Pupil-dilated
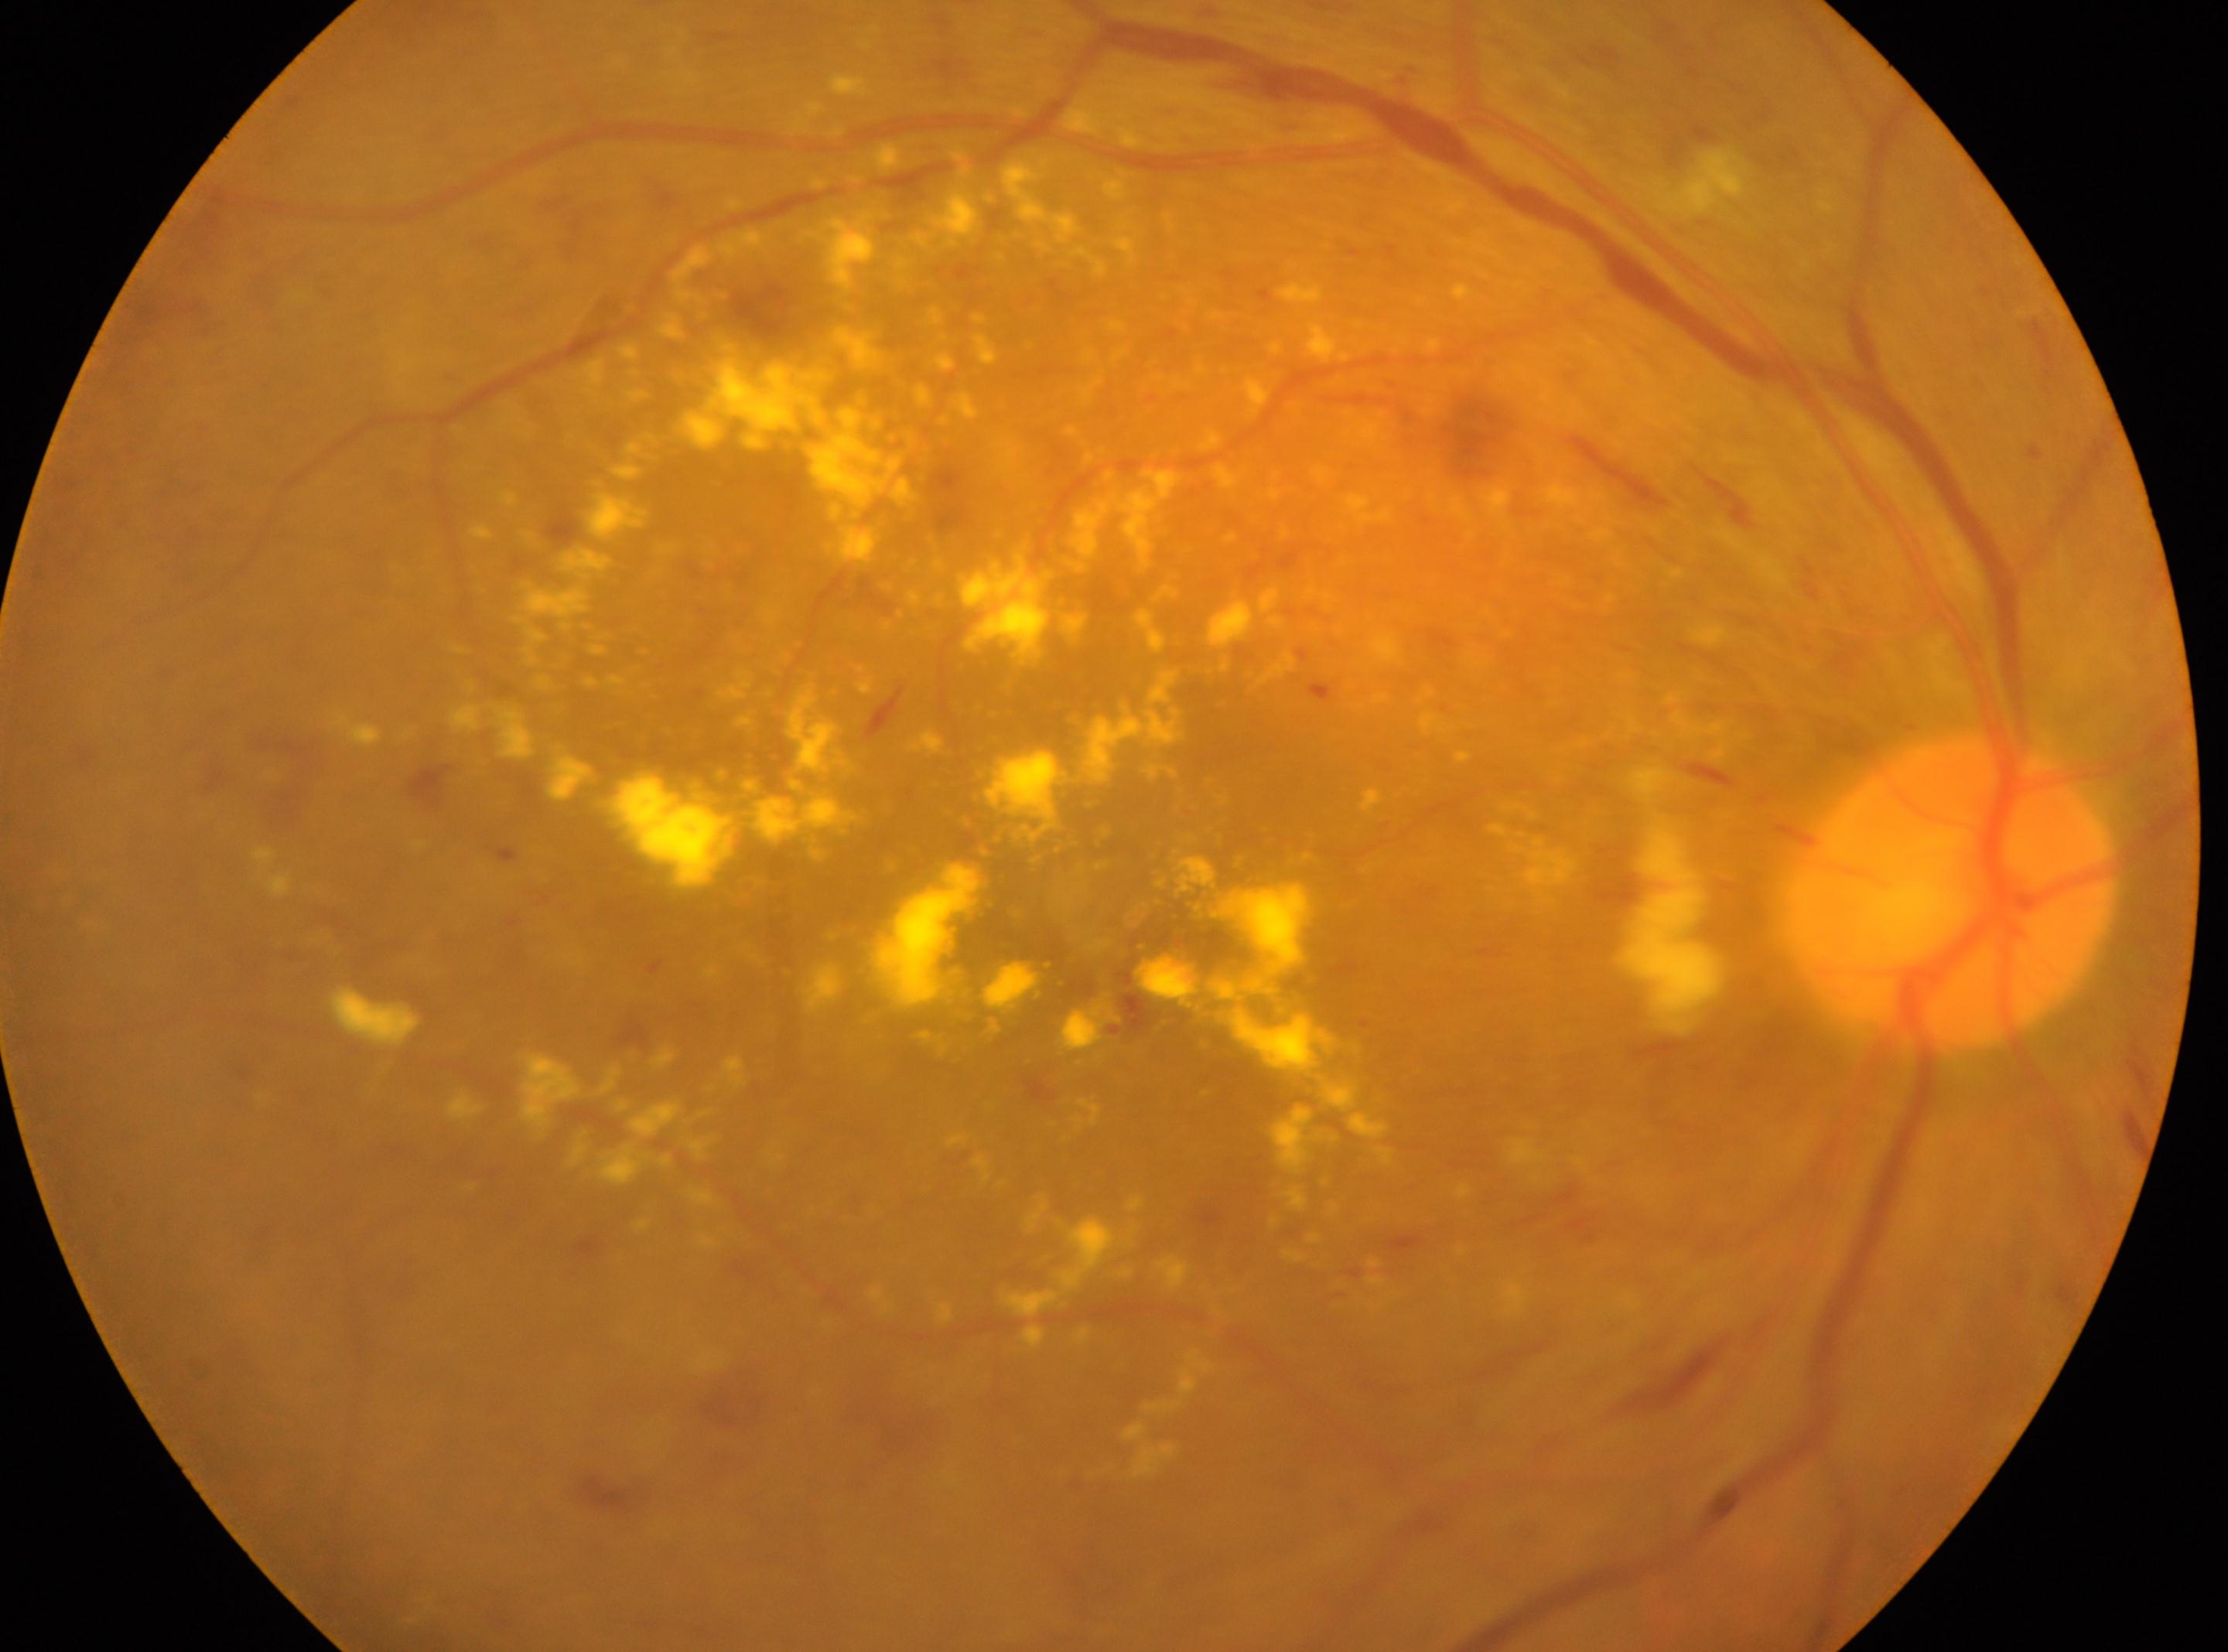

the optic disc=(1950,893)
right
fovea=(1119,951)
retinopathy grade=severe NPDR (3)